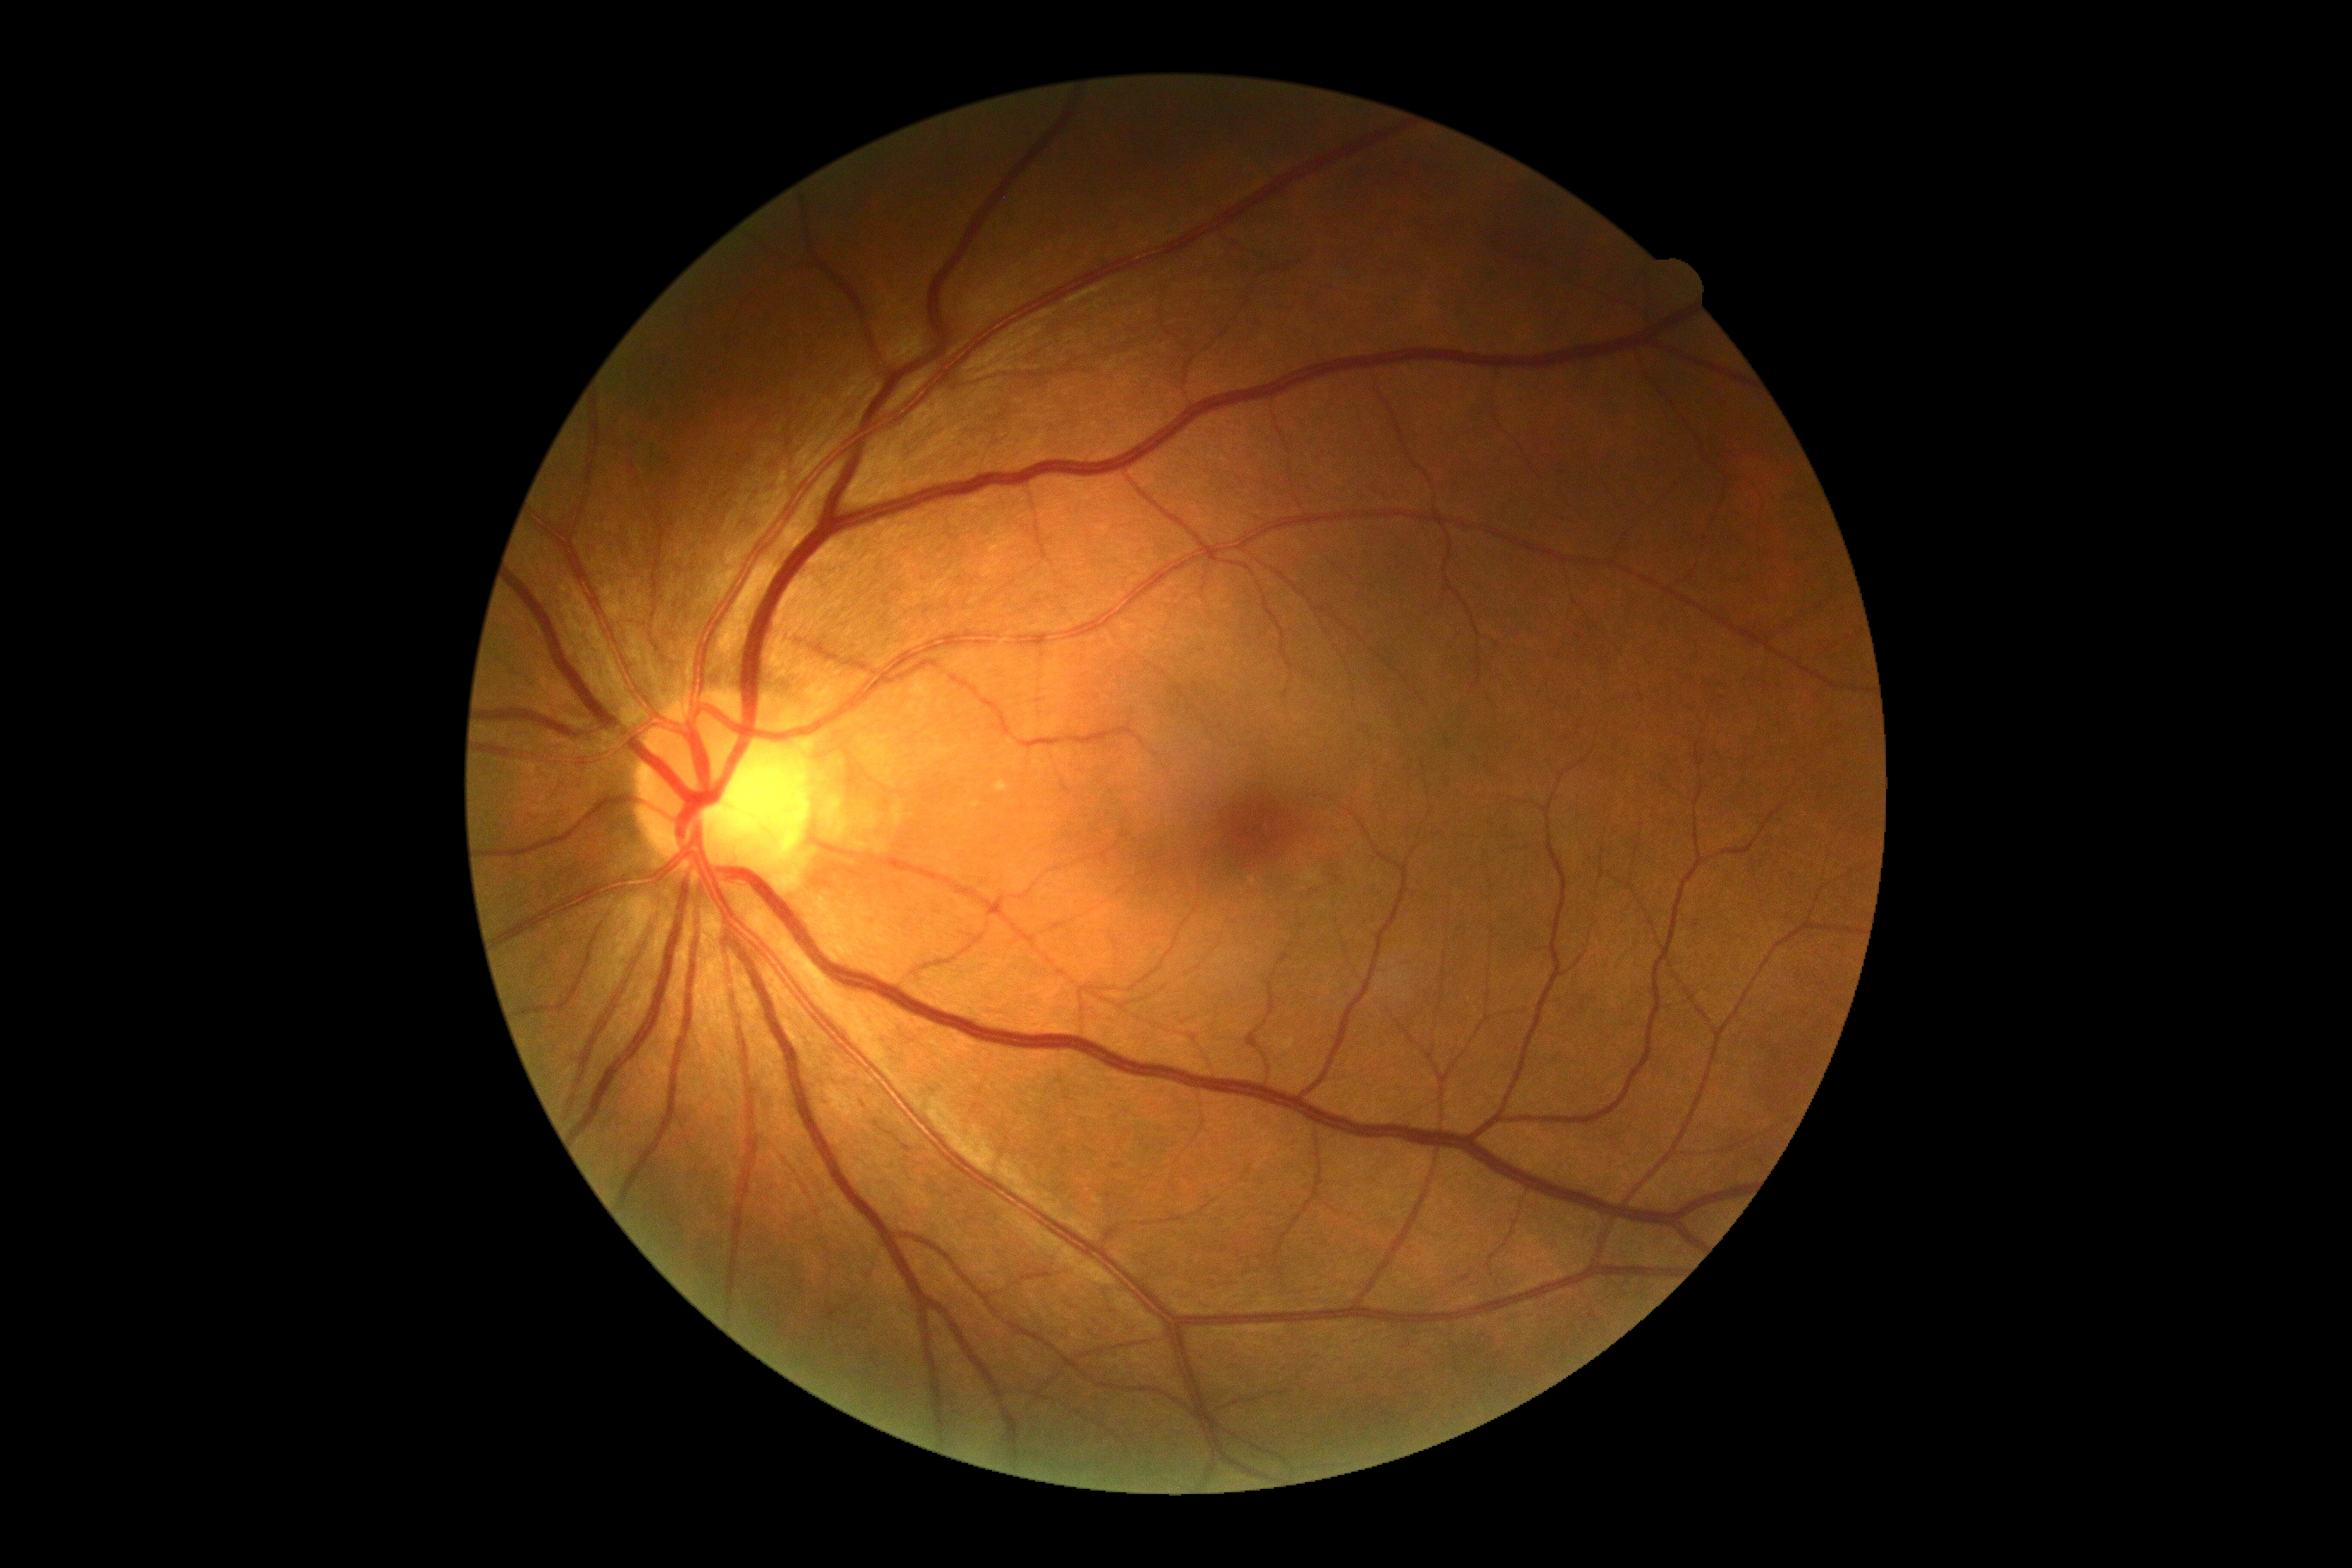 DR grade is 0 (no apparent retinopathy) — no visible signs of diabetic retinopathy.